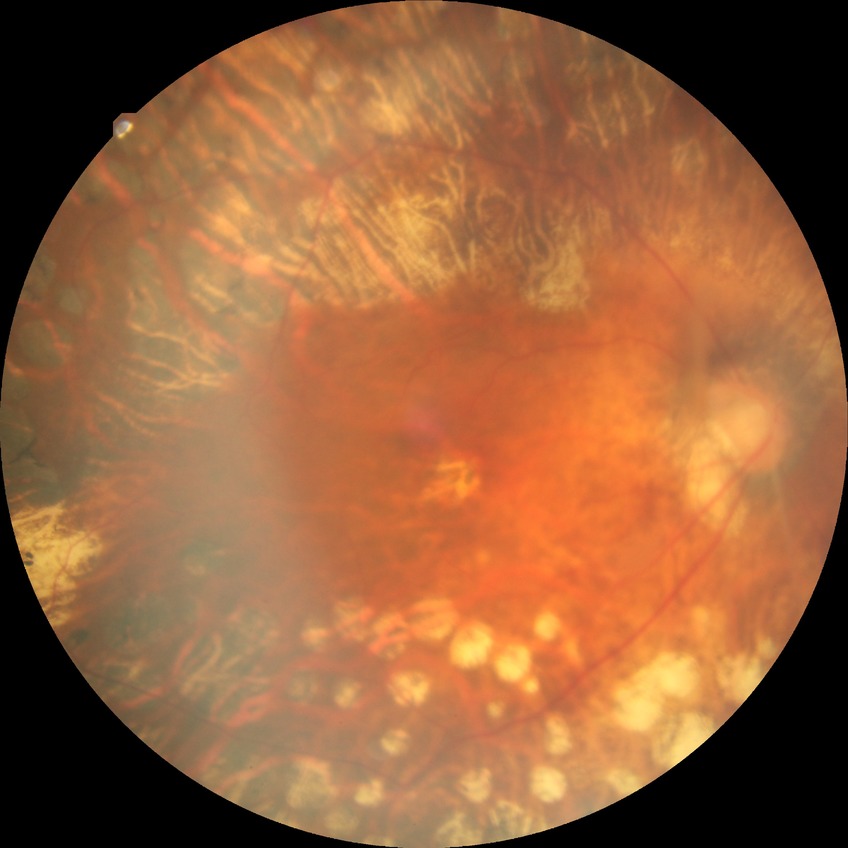
Diabetic retinopathy (DR) is proliferative diabetic retinopathy (PDR).